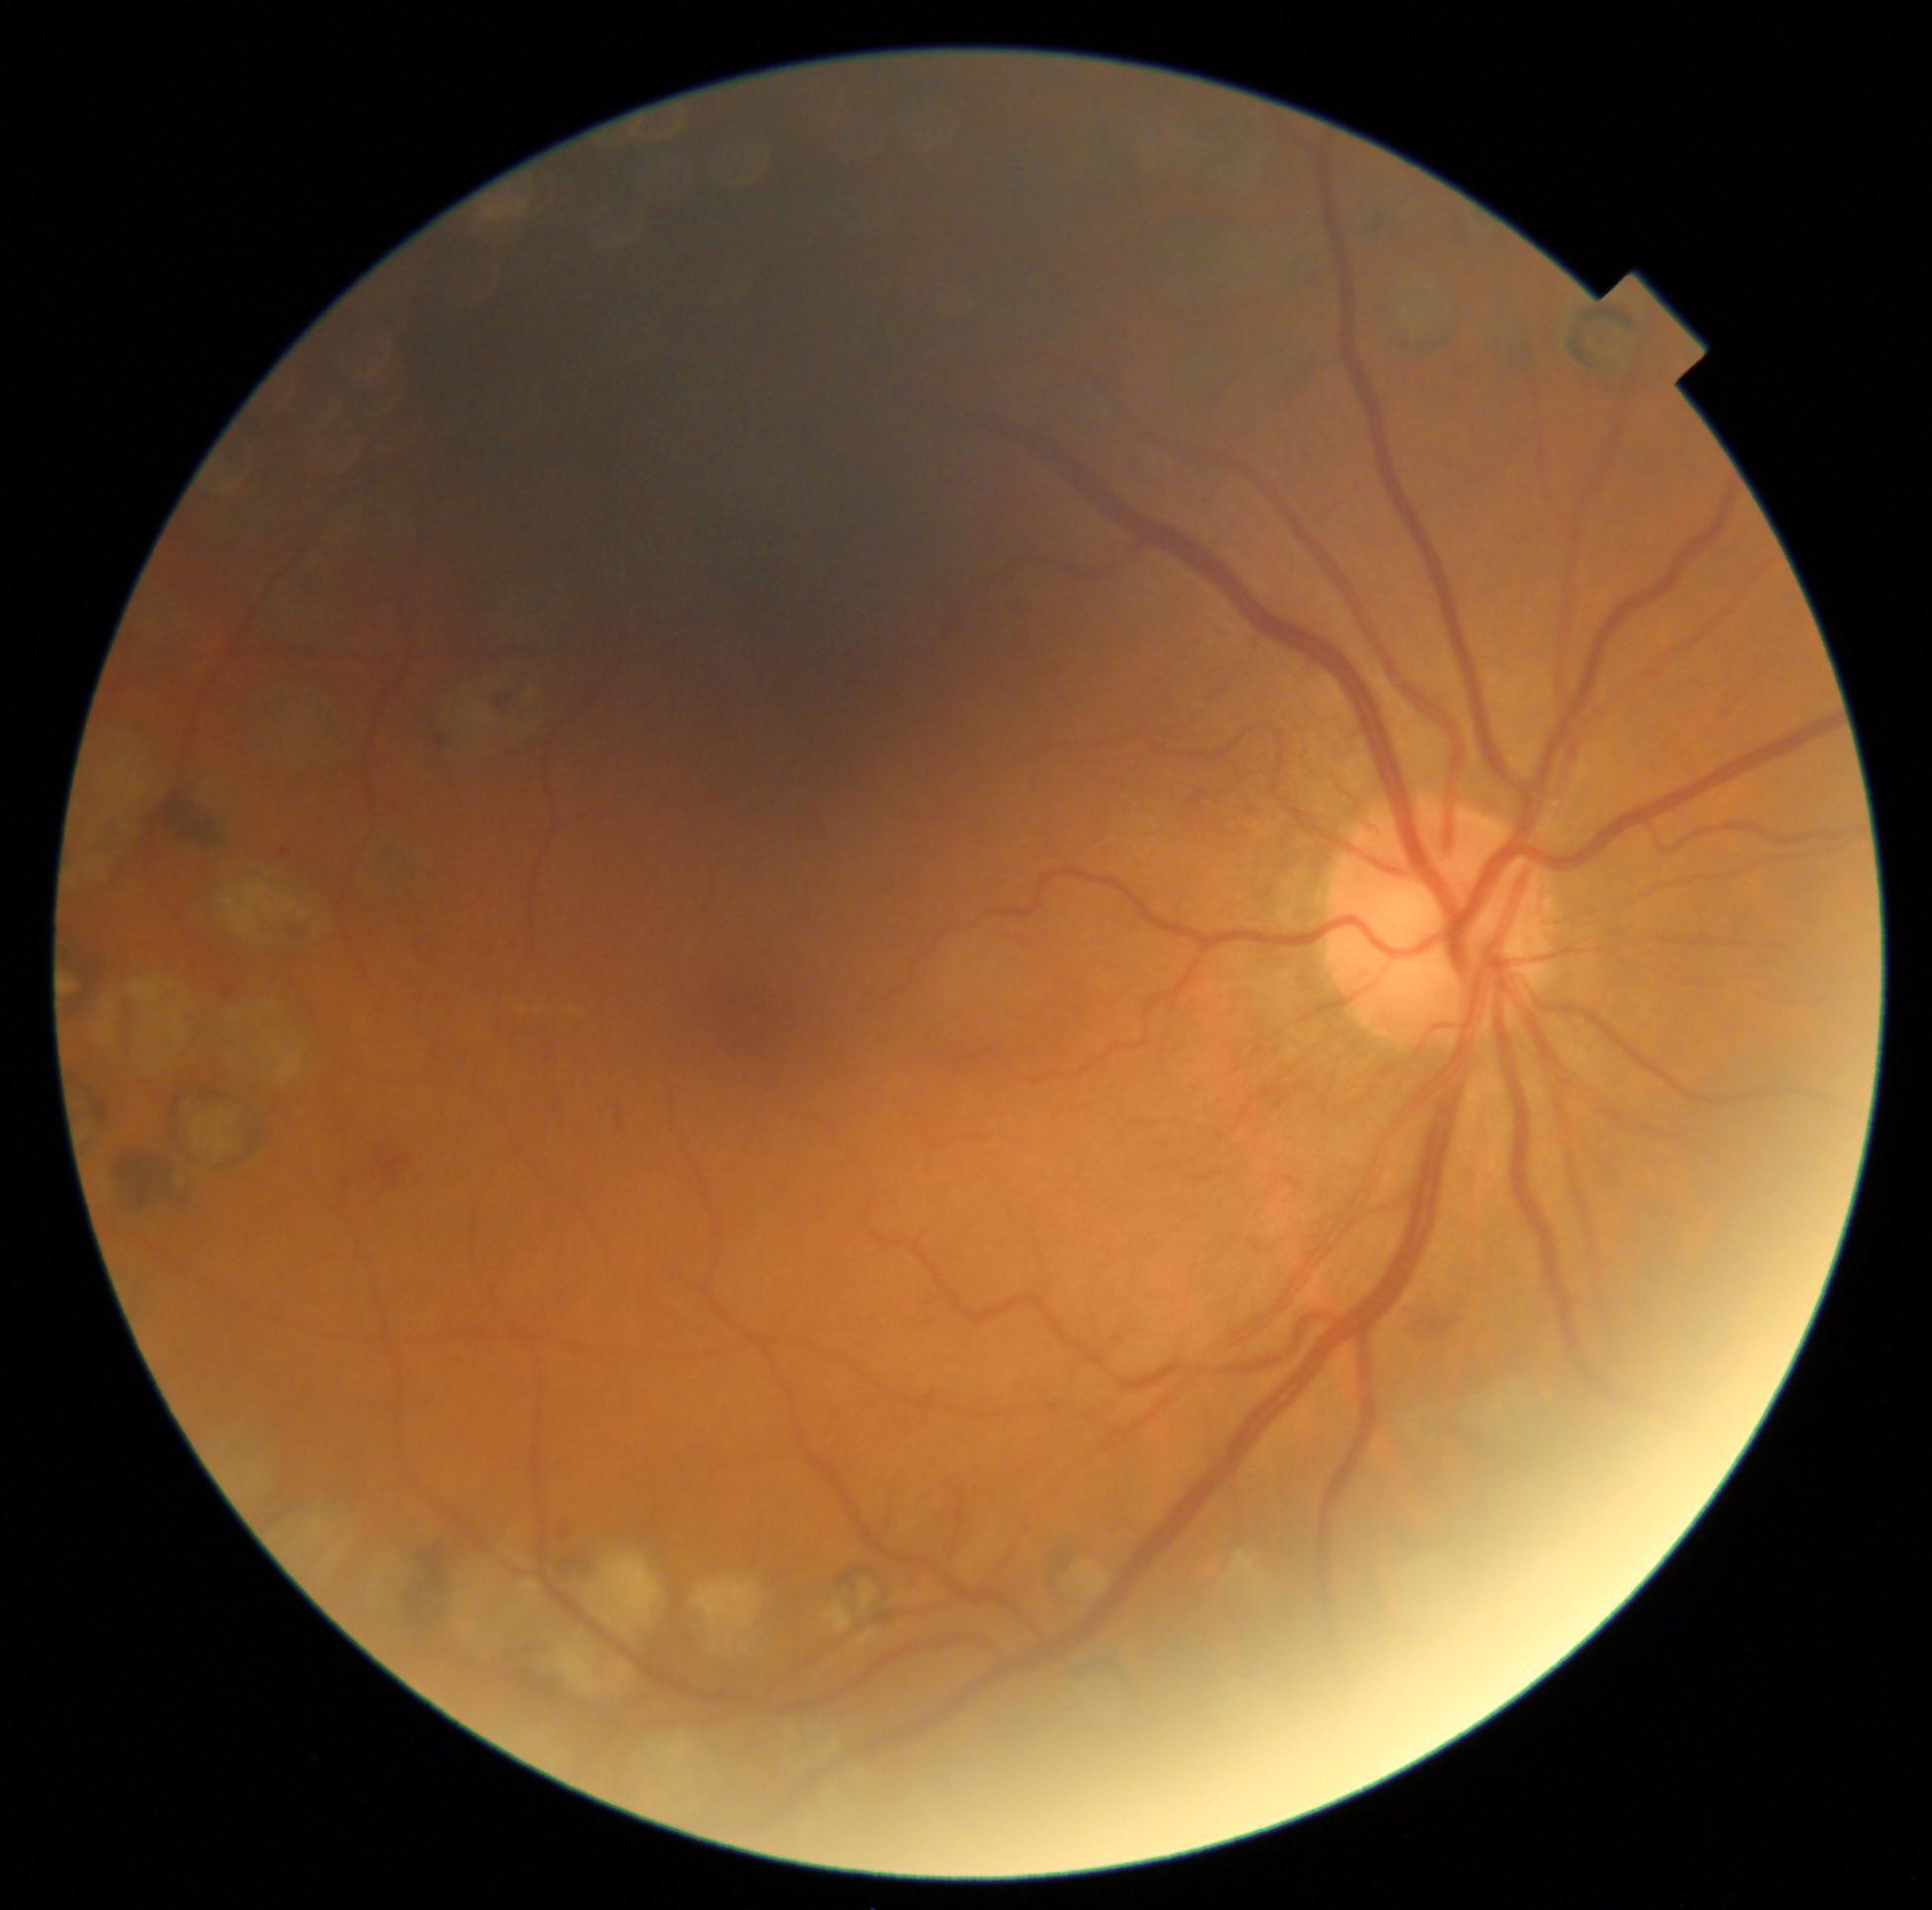 DR class = non-proliferative diabetic retinopathy, DR severity = grade 2 (moderate NPDR).